Ultra-widefield (UWF) fundus image:
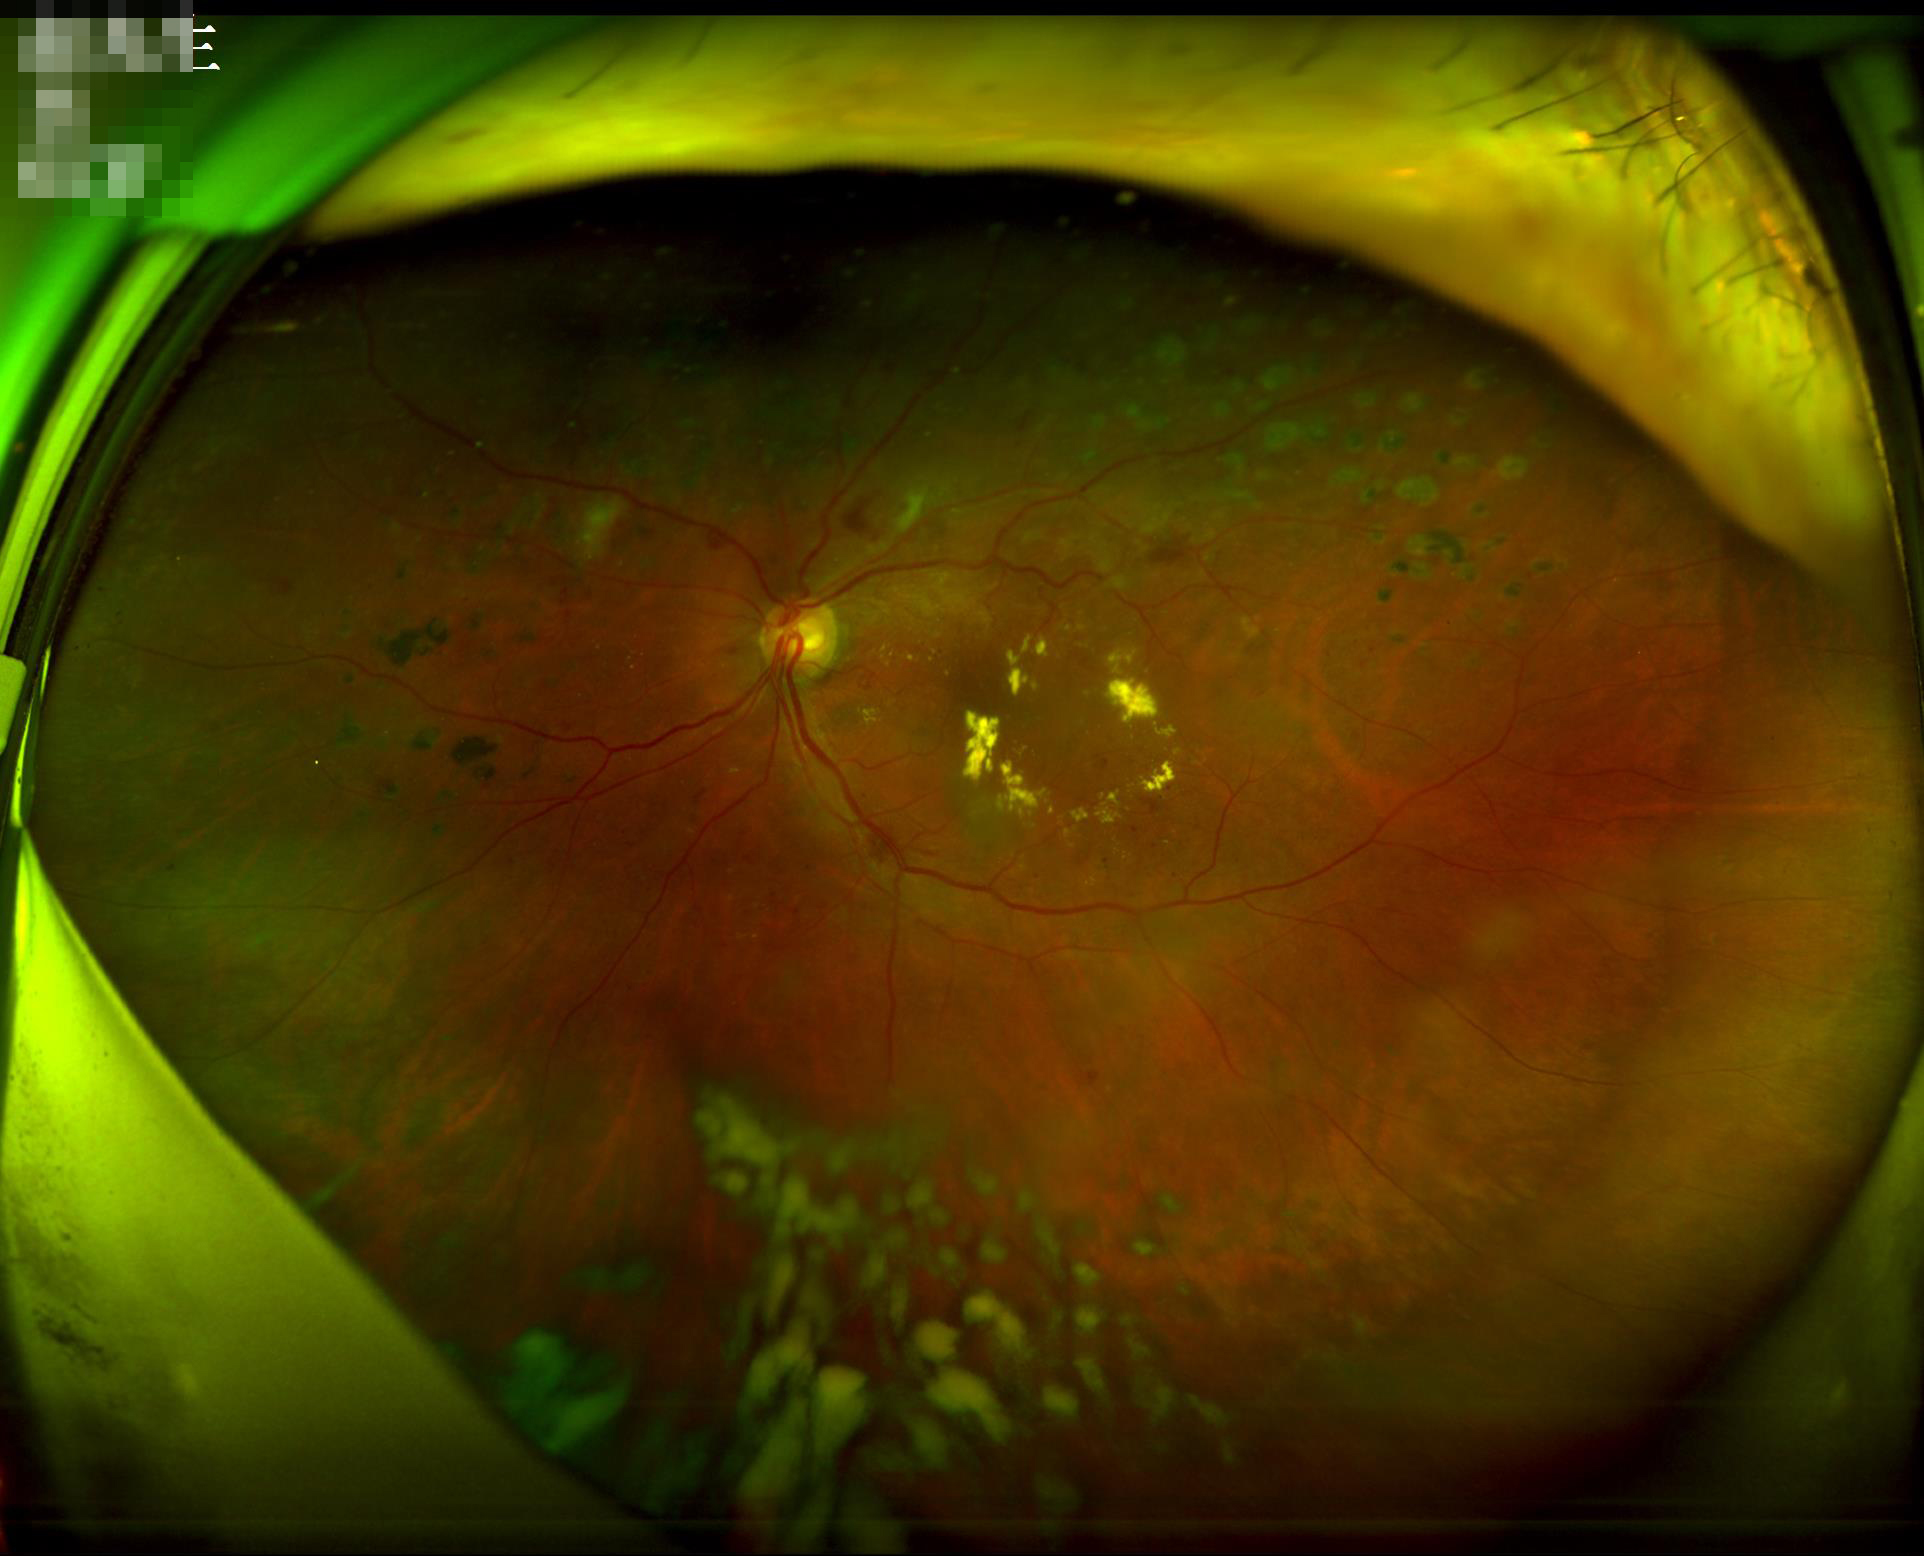 Image quality assessment: clarity: optic disc, vessels, and background in focus; overall: adequate for clinical interpretation; contrast: good dynamic range; illumination: over- or under-exposed.